Wide-field fundus photograph of an infant · Clarity RetCam 3, 130° FOV
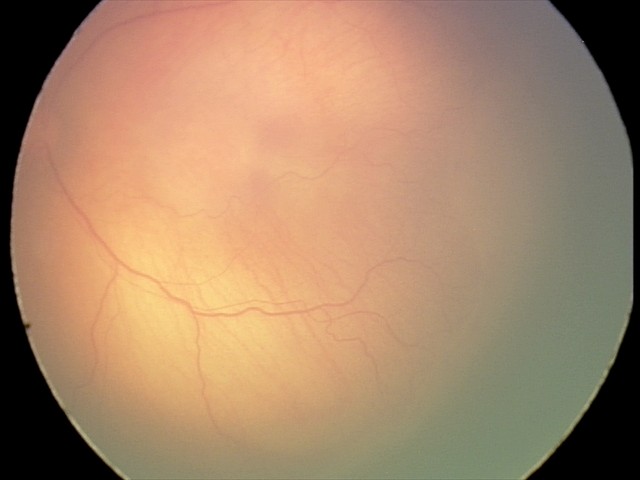
Examination diagnosed as ROP stage 1. Plus disease absent.